Infant wide-field retinal image · 1440 by 1080 pixels · Natus RetCam Envision, 130° FOV:
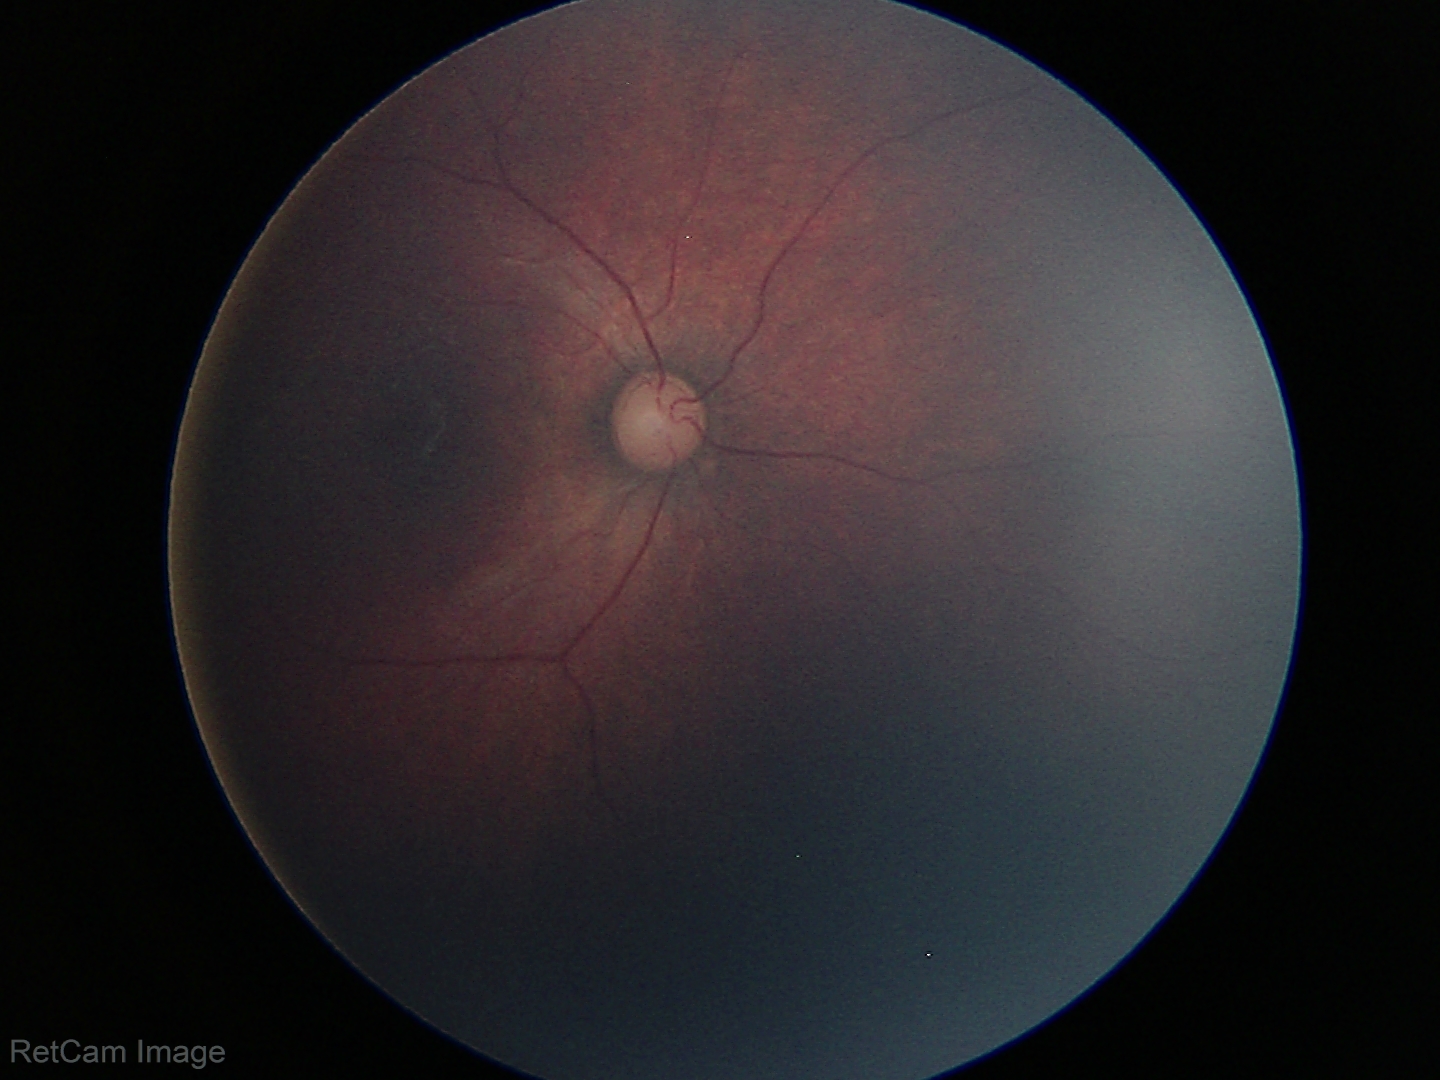
Q: What was the screening finding?
A: physiological retinal finding